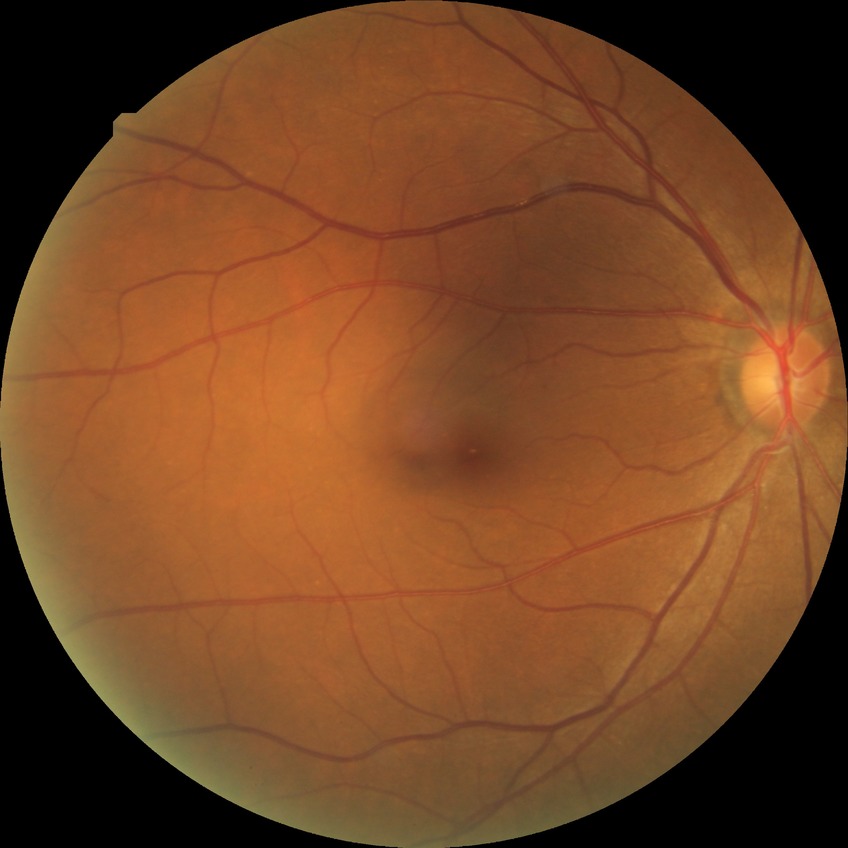 Diabetic retinopathy (DR): no diabetic retinopathy (NDR).